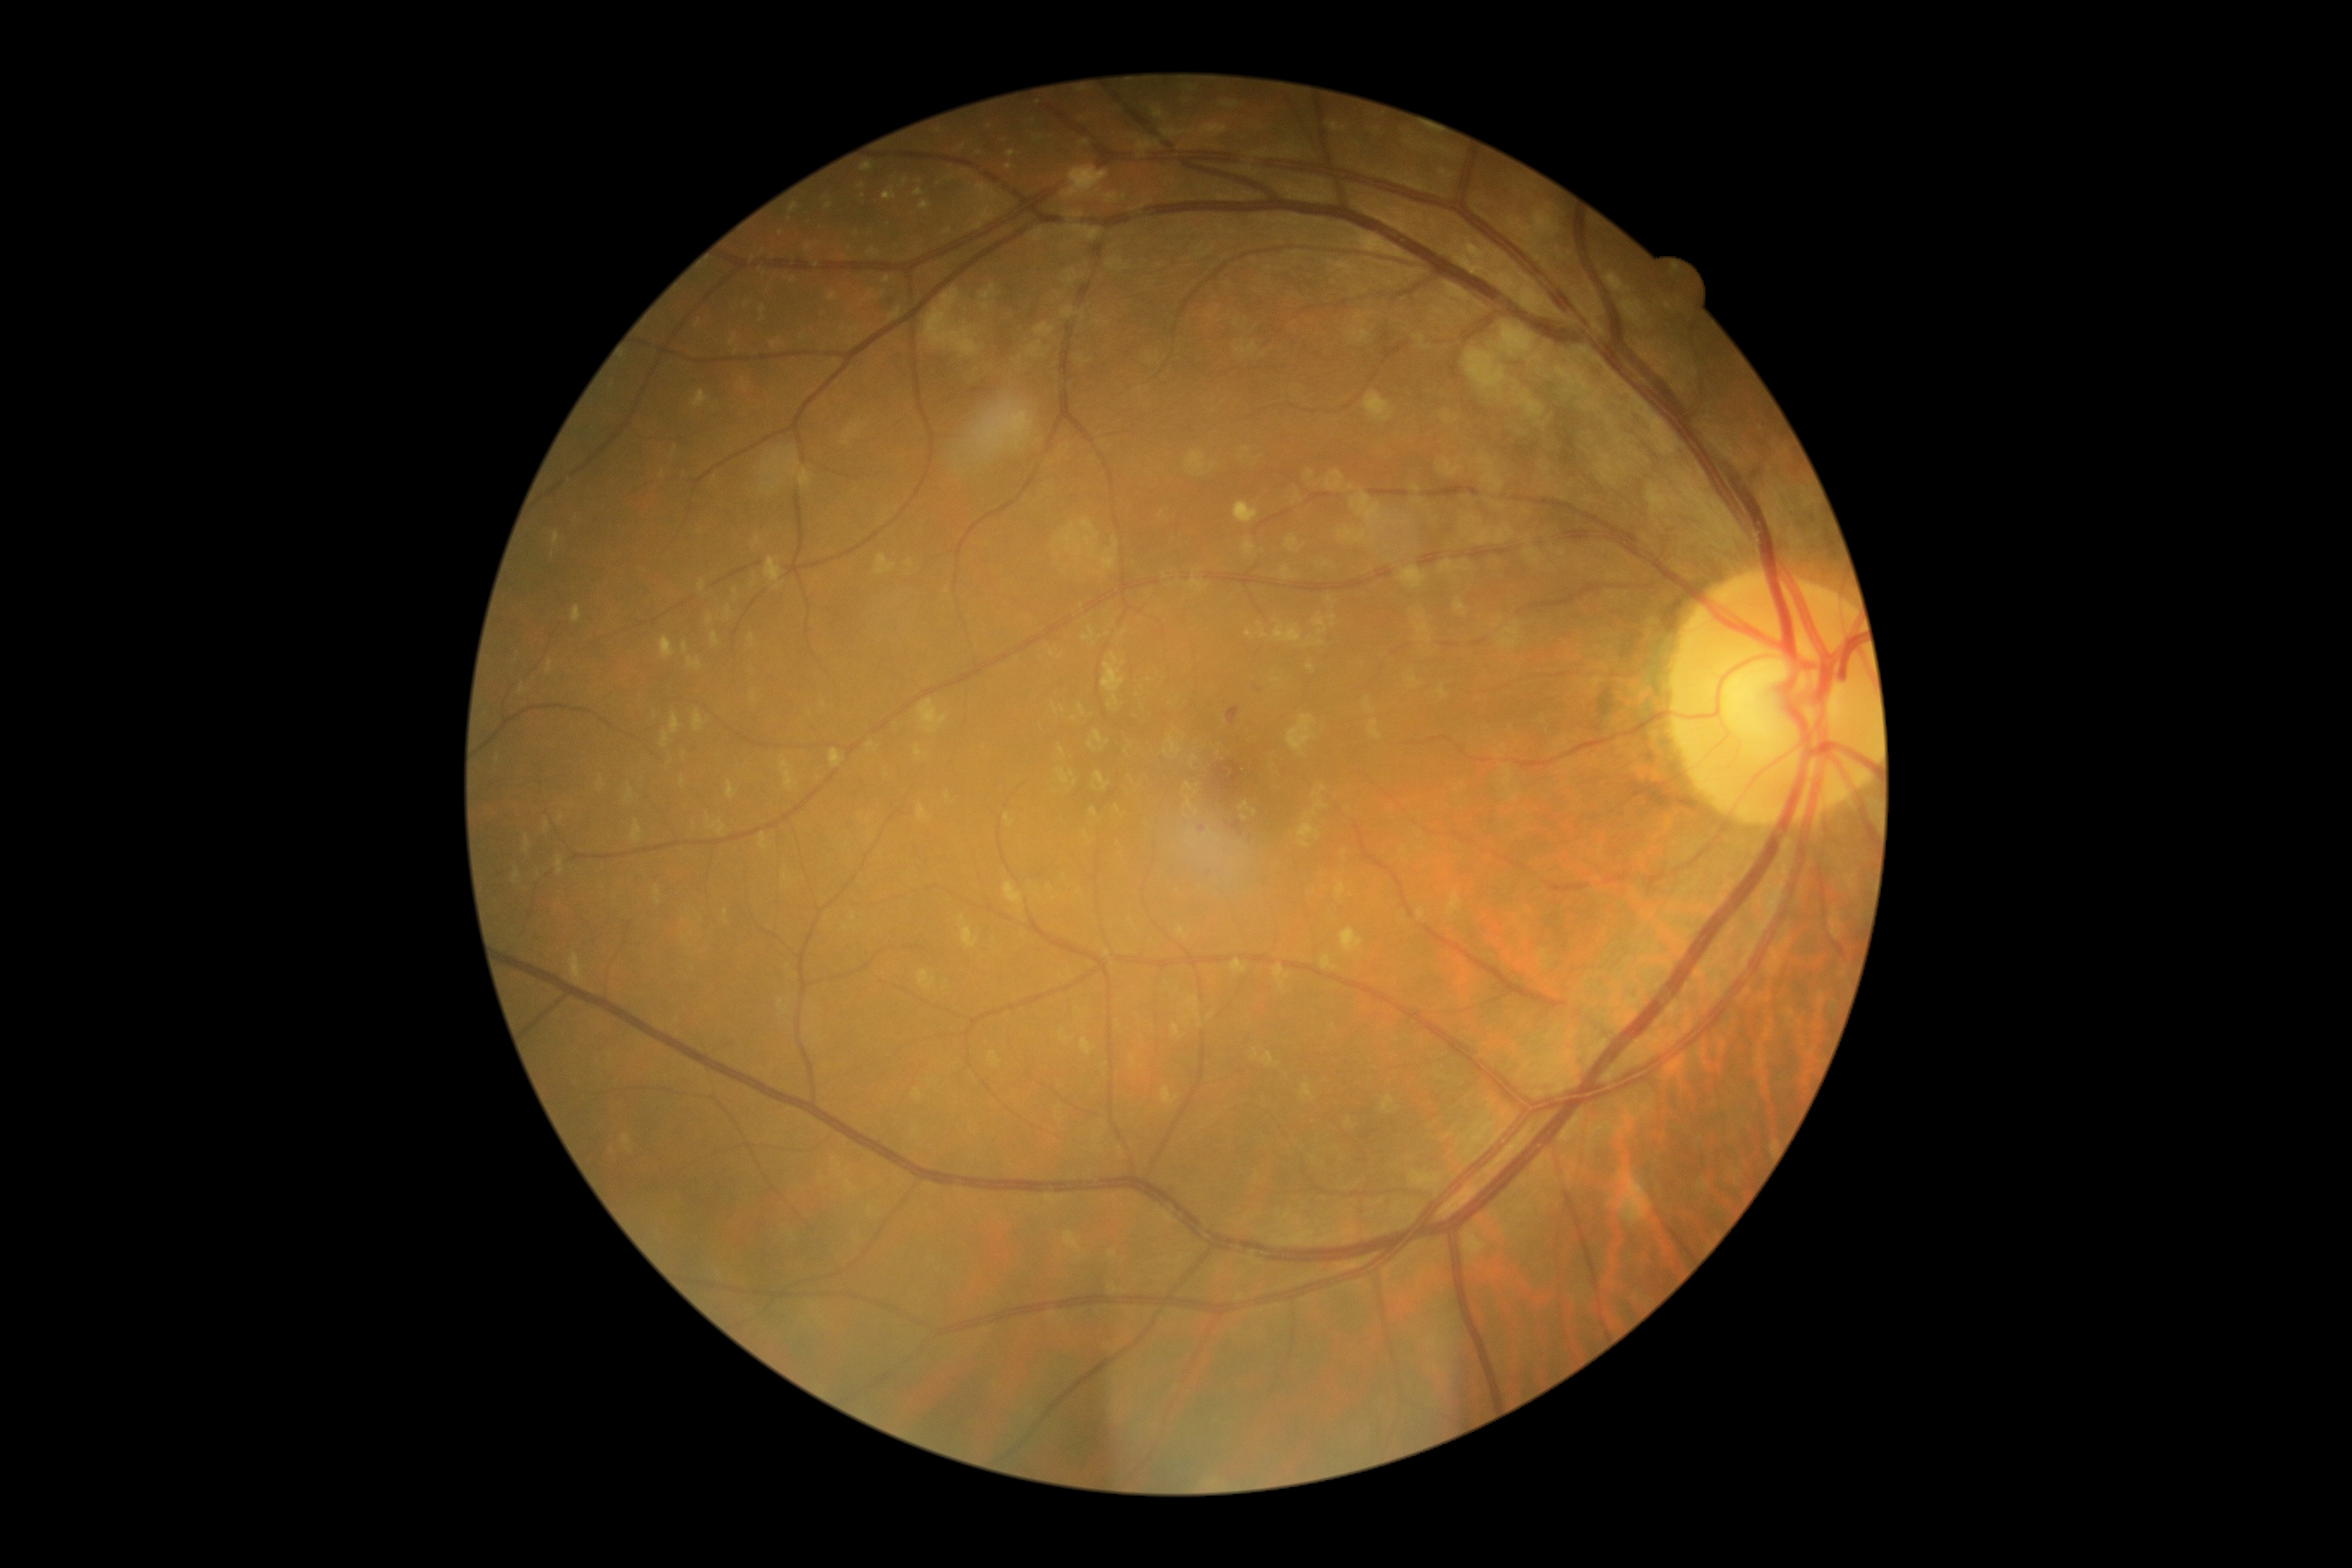
– DR severity — mild non-proliferative diabetic retinopathy (grade 1)